100° field of view (Phoenix ICON) · wide-field fundus image from infant ROP screening — 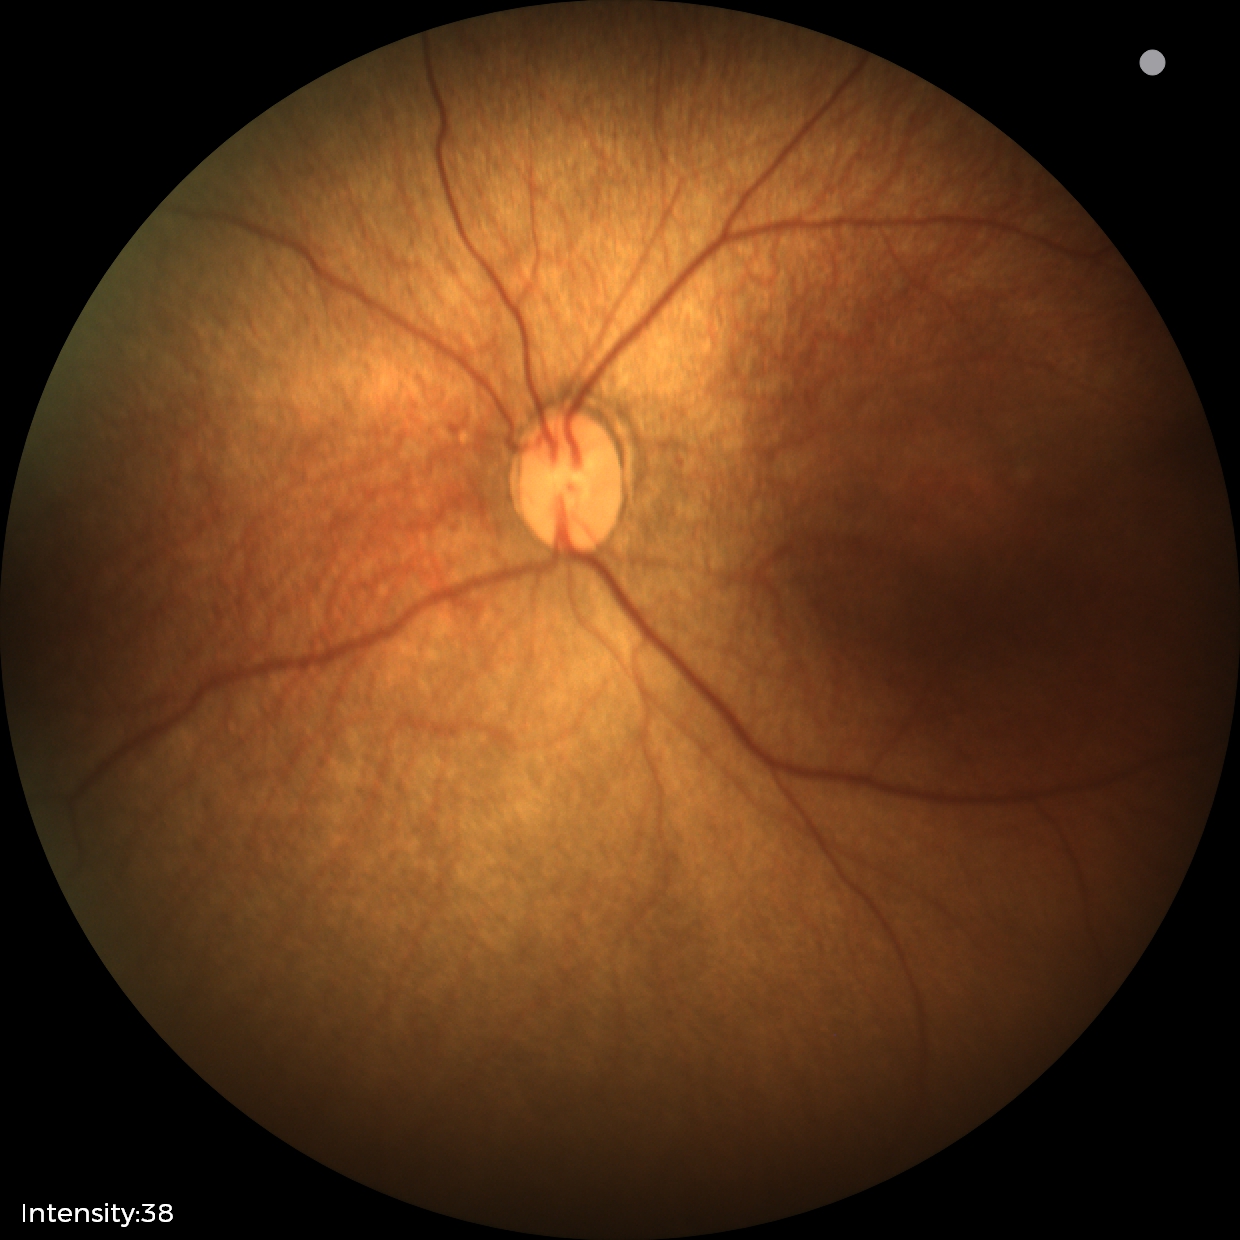 Screening diagnosis: status post ROP.